Image size 2352x1568.
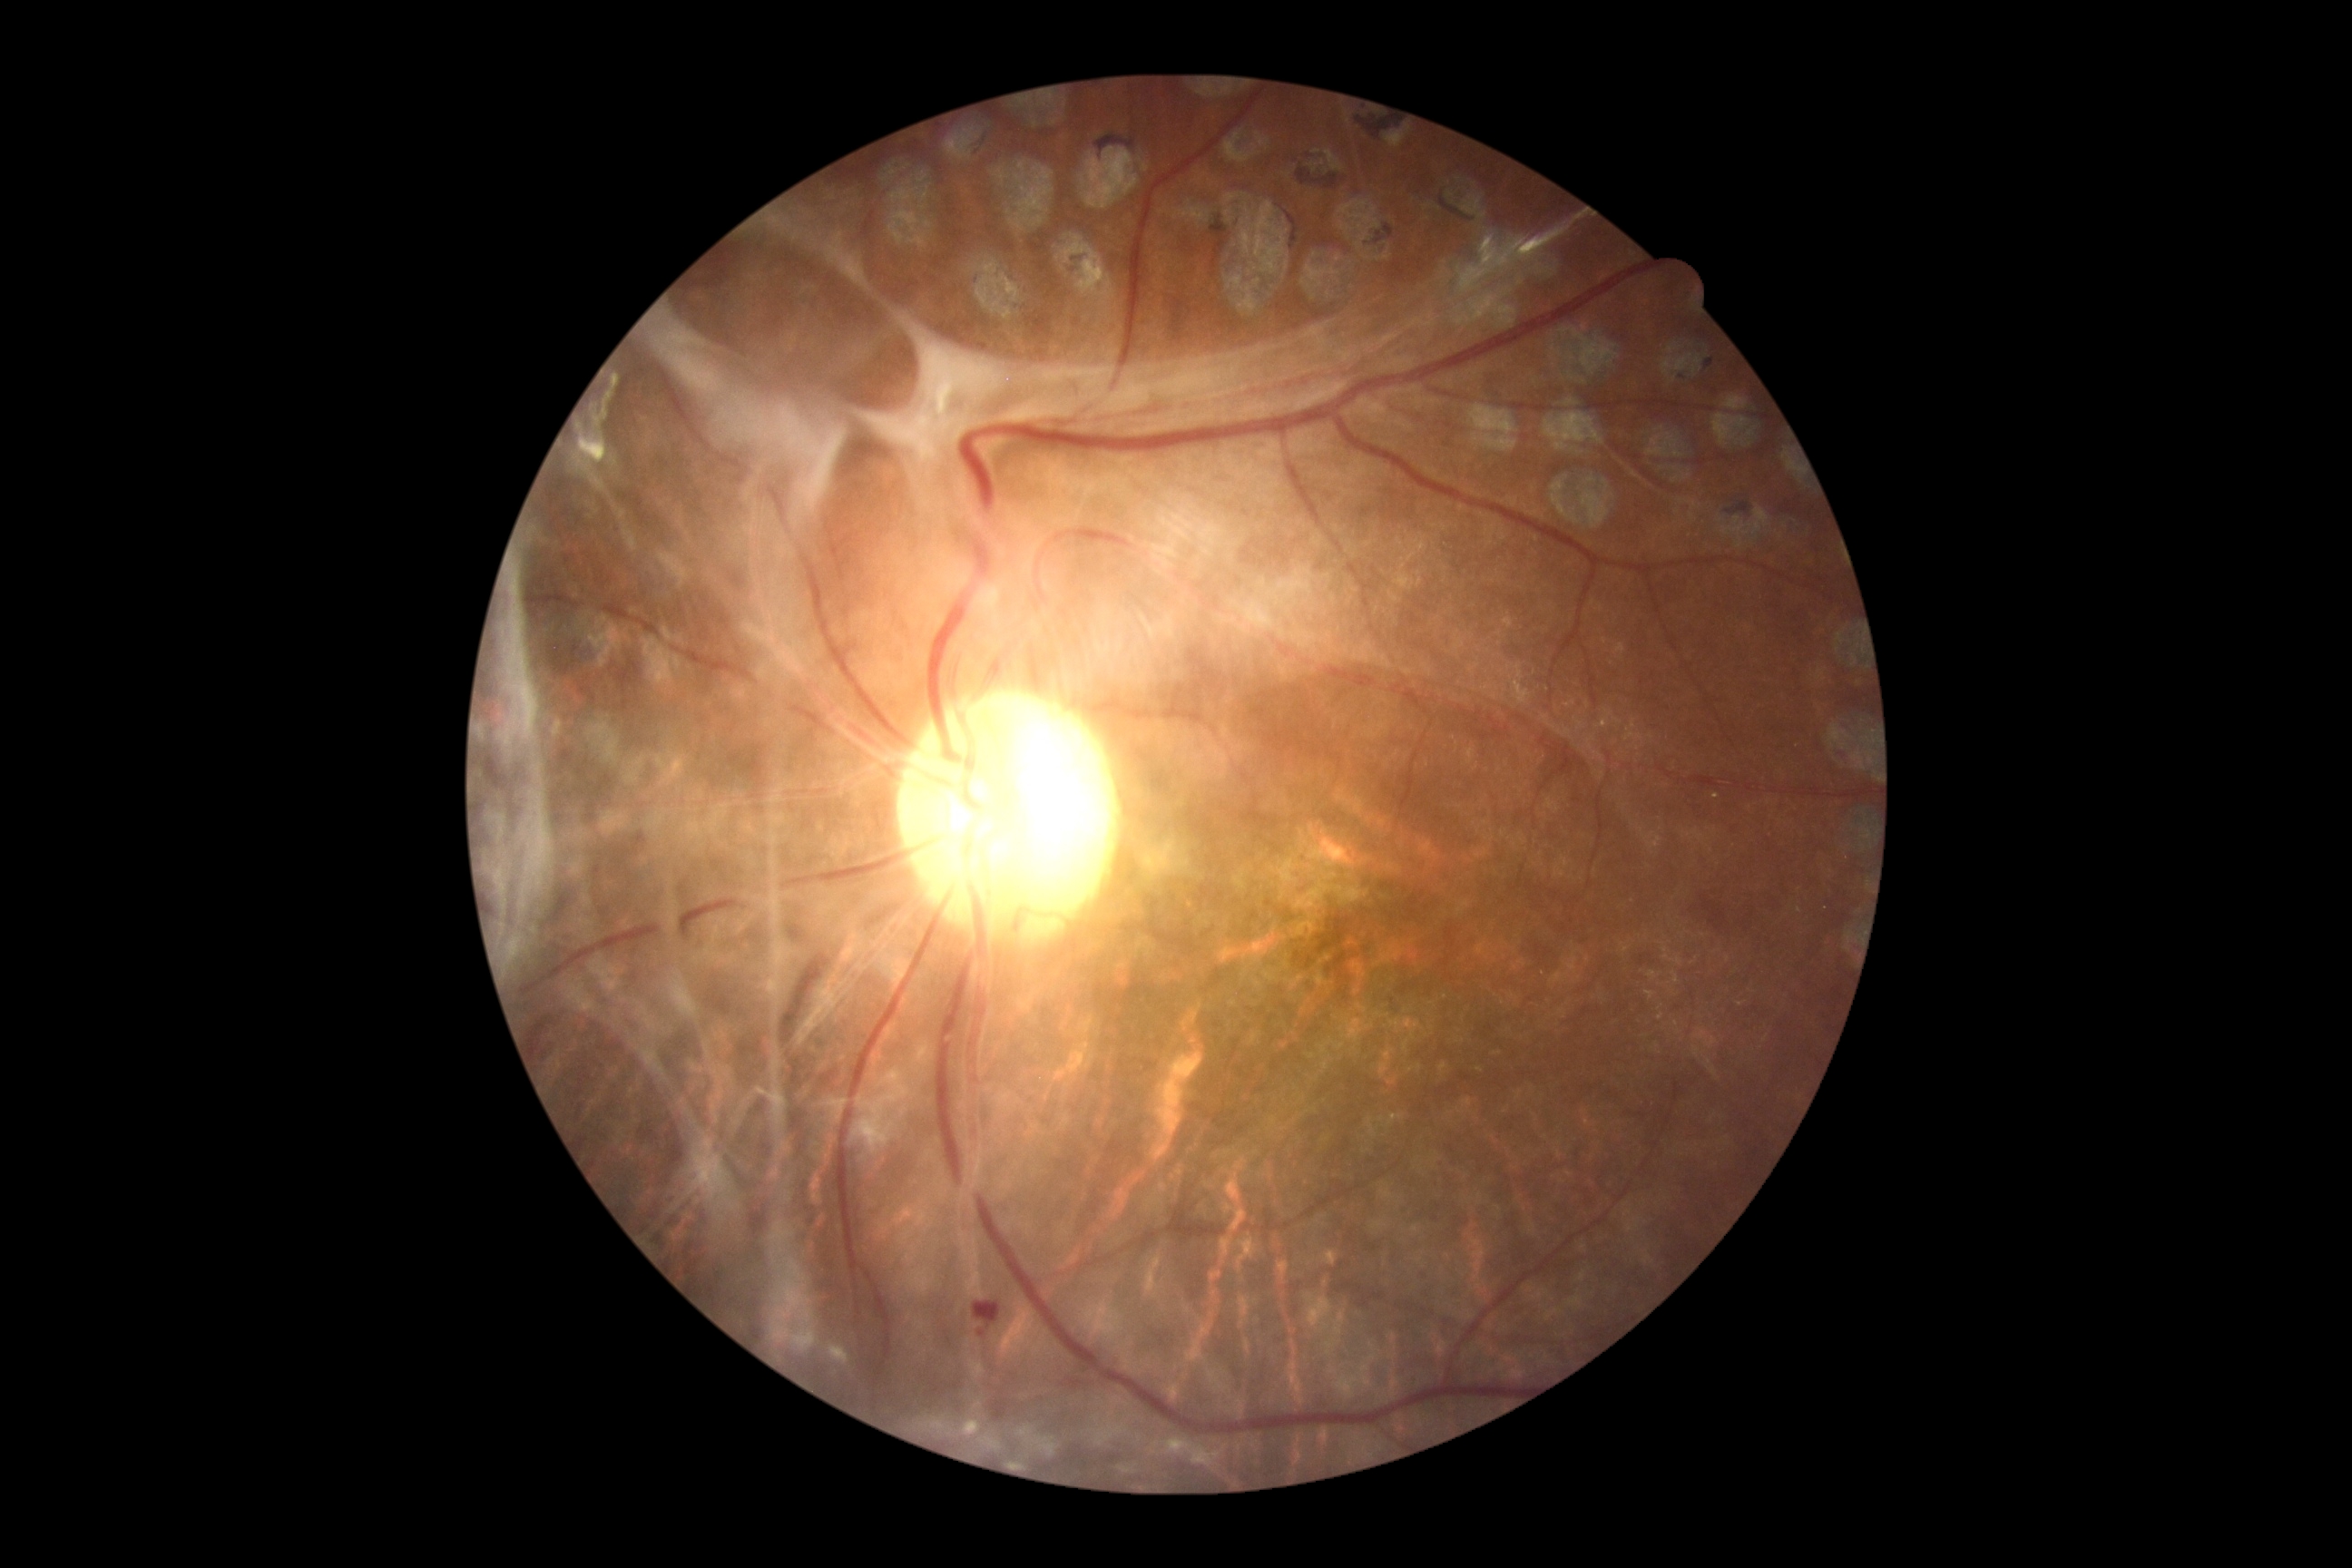
Retinopathy: 4 — neovascularization and/or vitreous/pre-retinal hemorrhage.